DR severity per modified Davis staging.
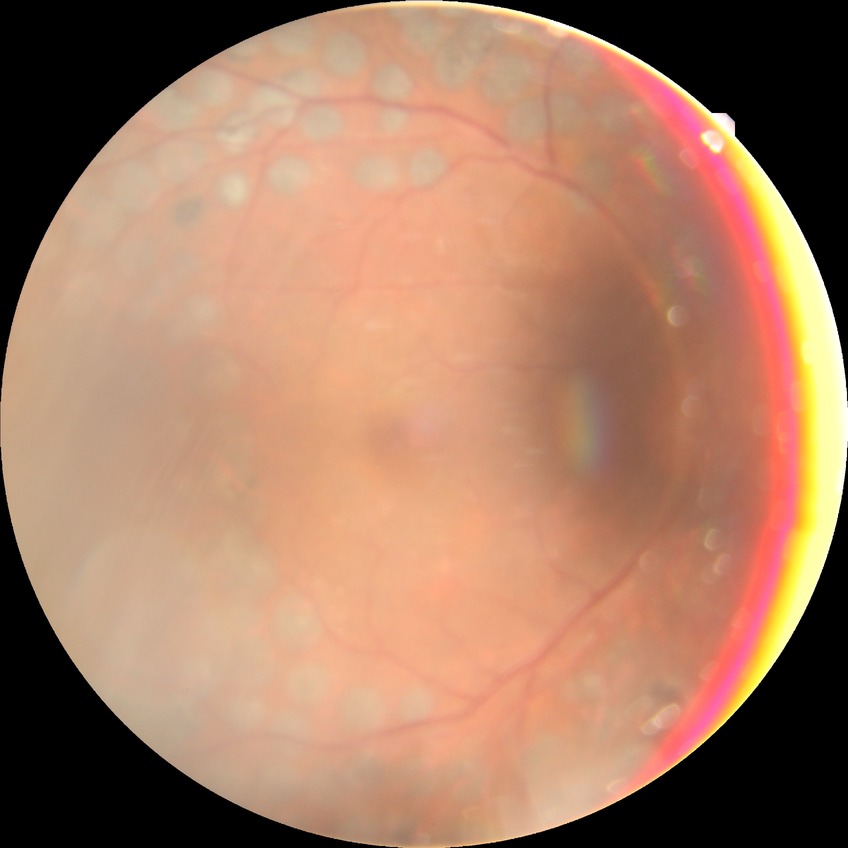

Assessment:
– diabetic retinopathy stage: proliferative diabetic retinopathy